Diabetic retinopathy graded by the modified Davis classification, 848 x 848 pixels, retinal fundus photograph.
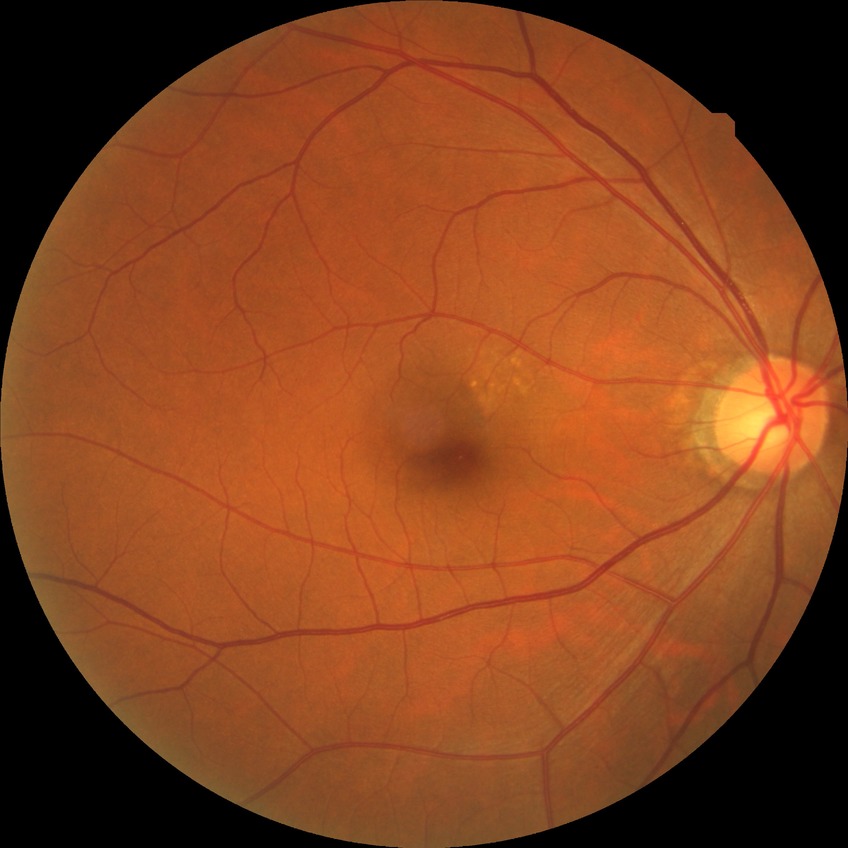 diabetic retinopathy (DR): NDR (no diabetic retinopathy).